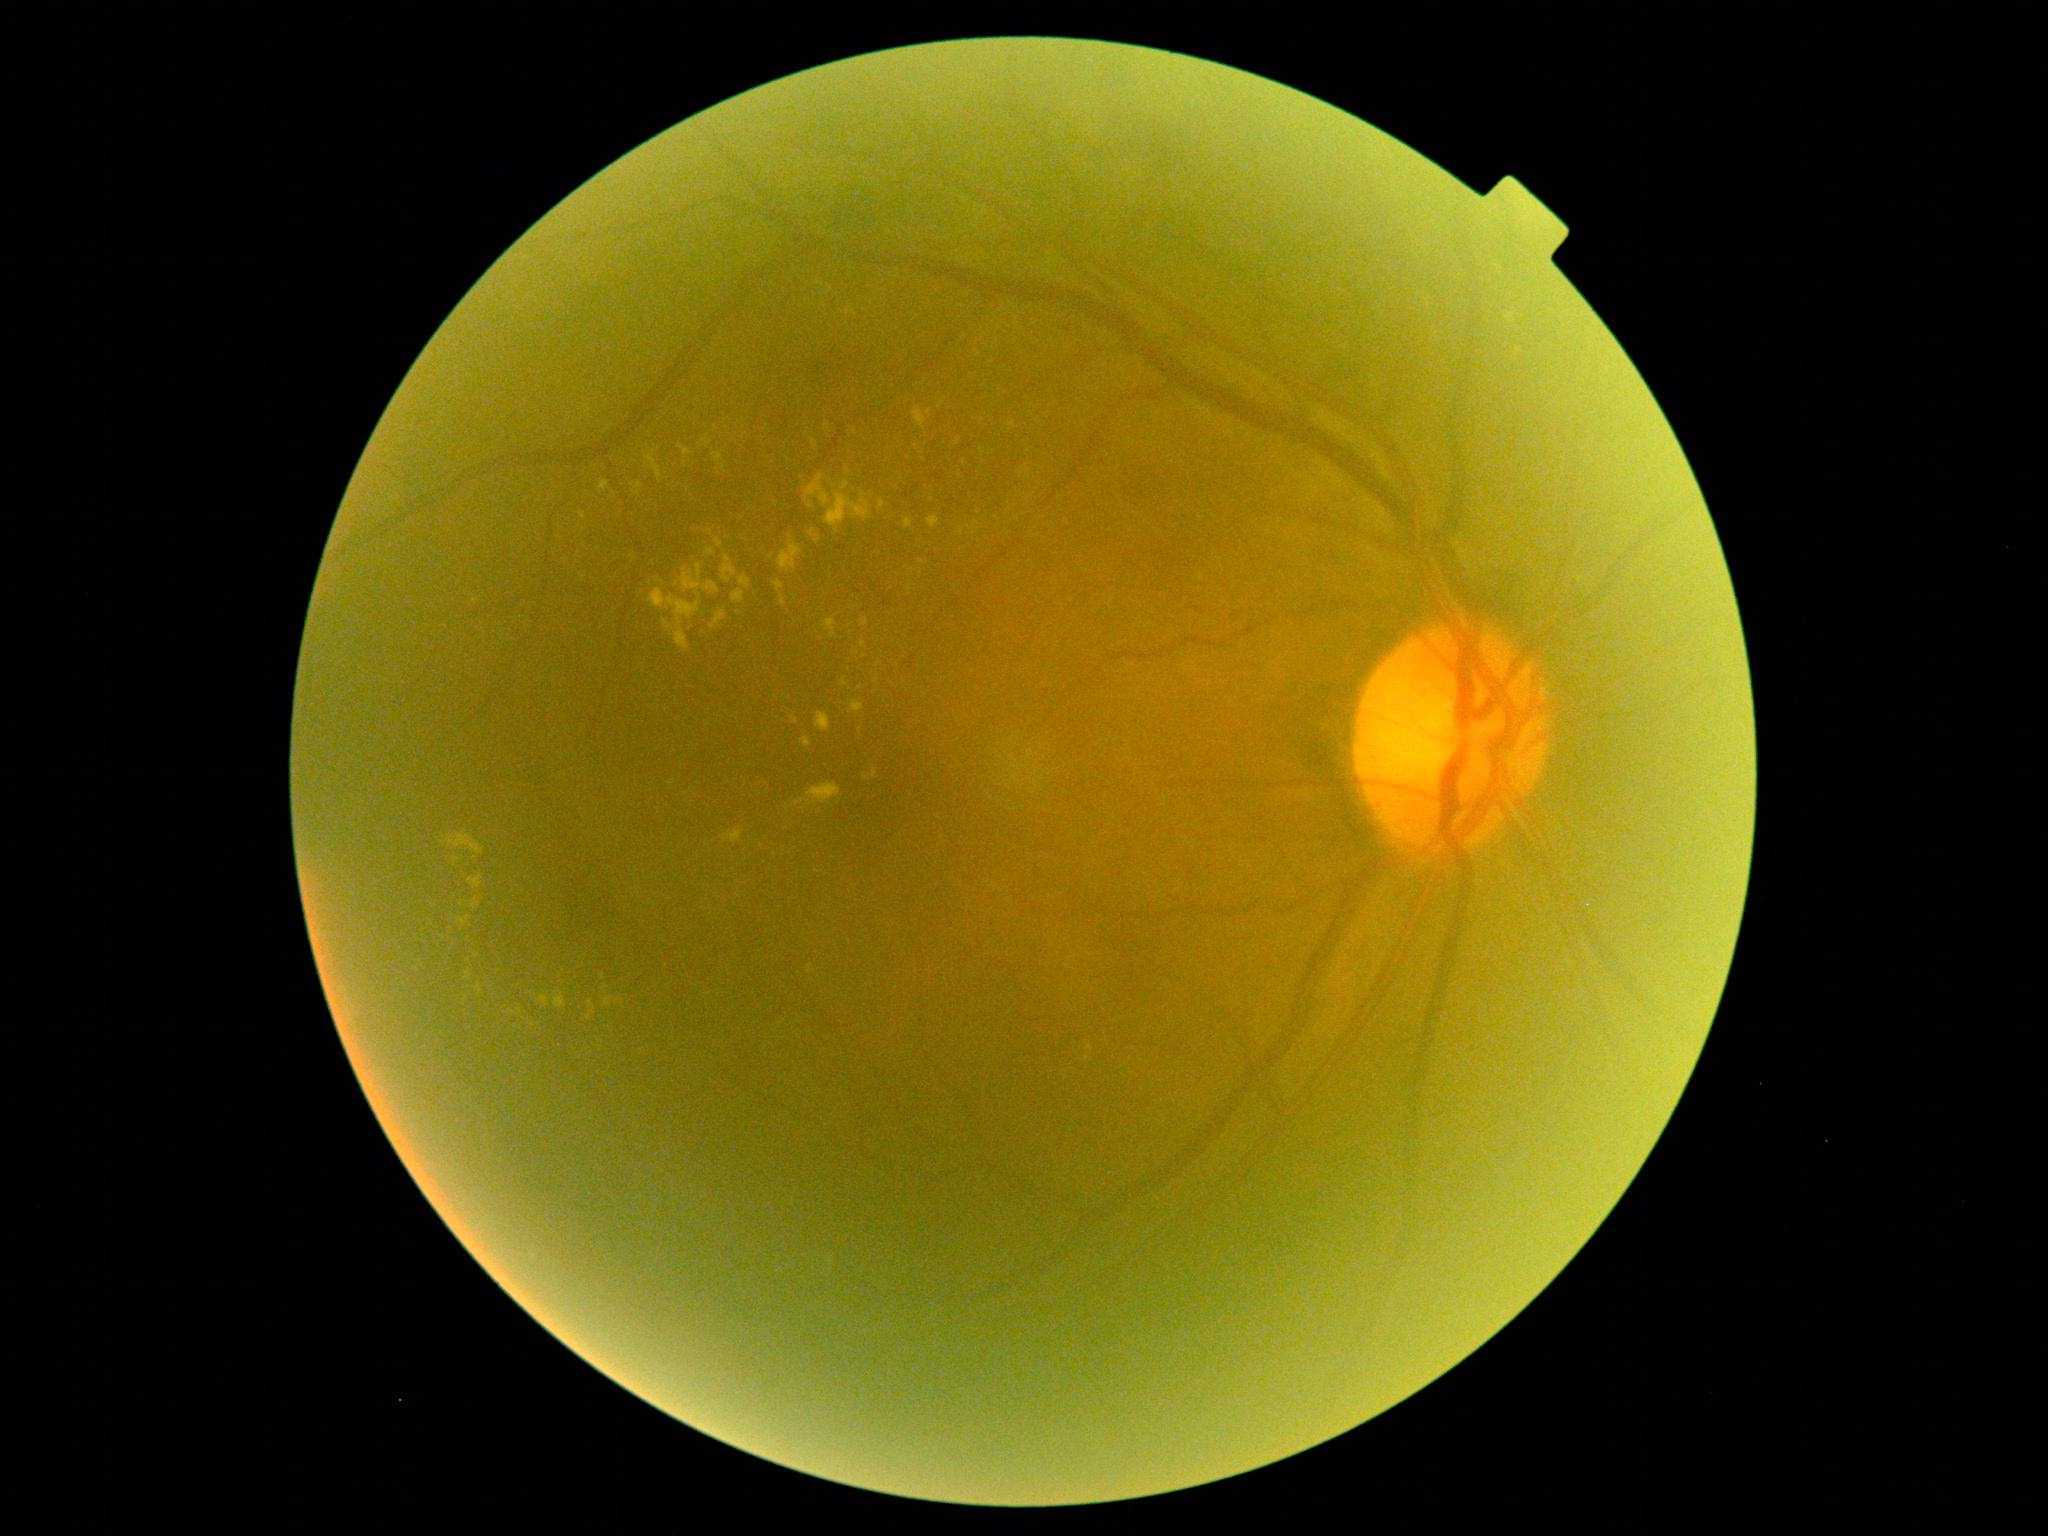

Diabetic retinopathy severity: 2.